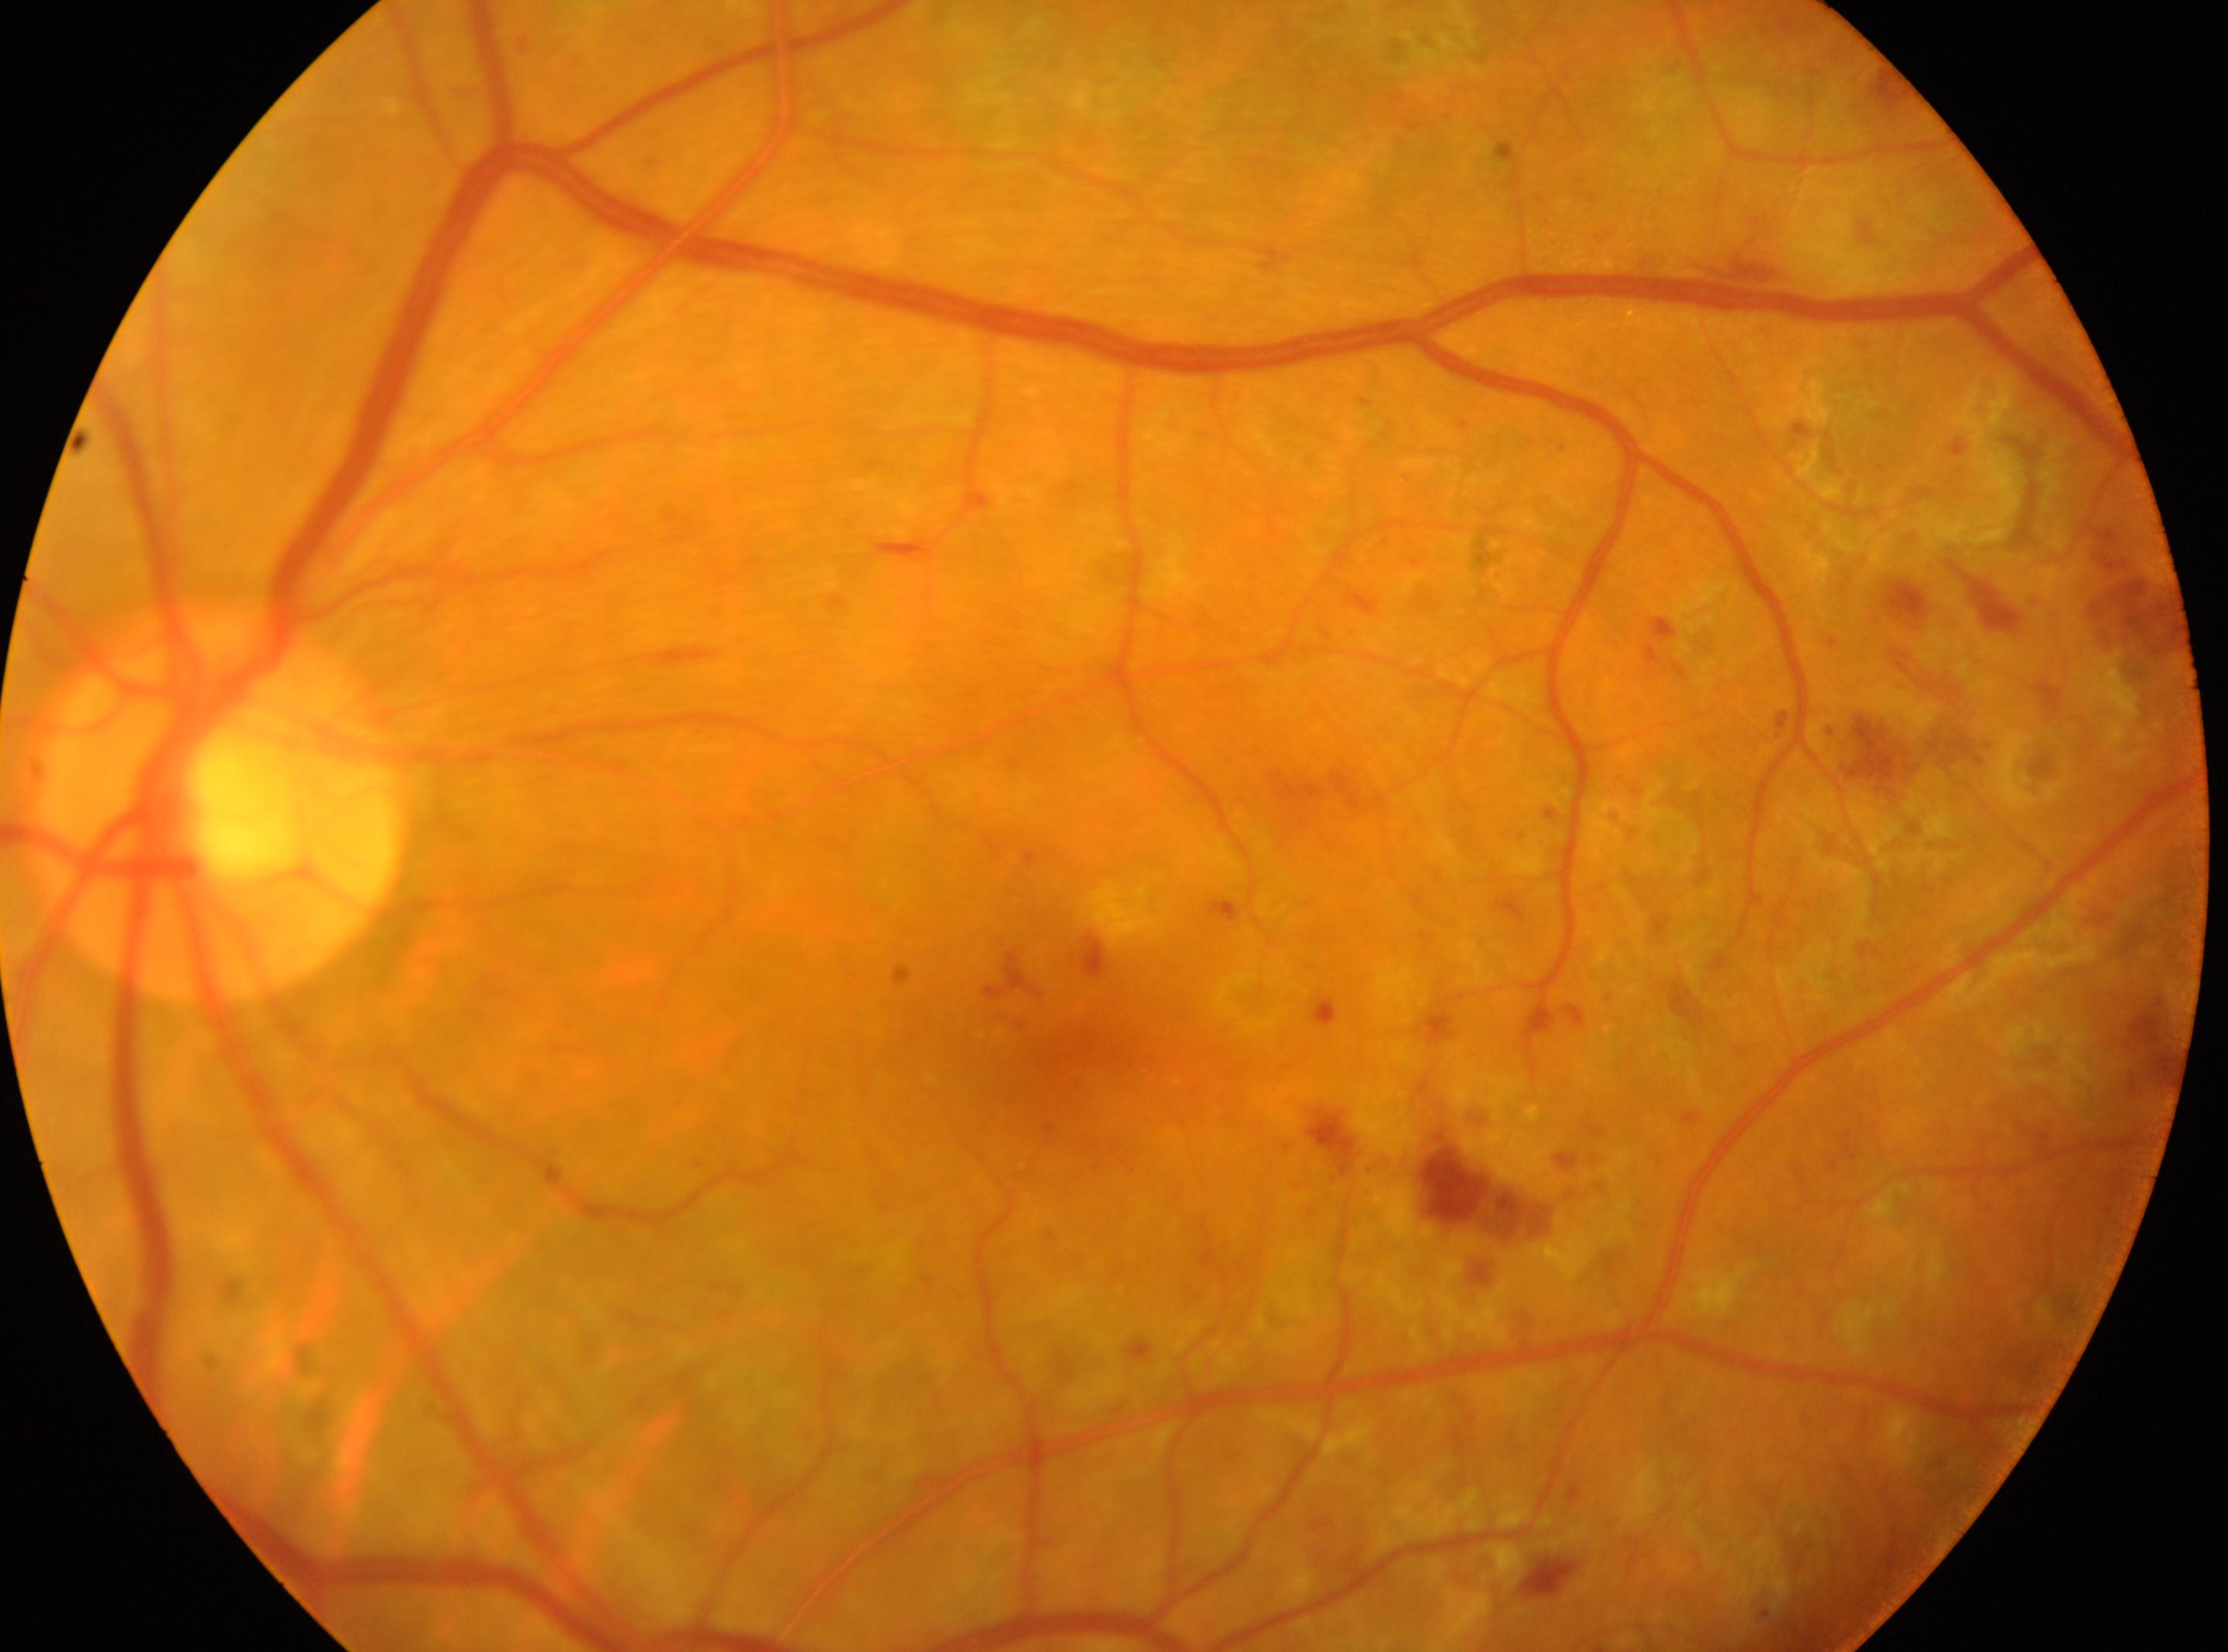 DR: post-laser DR, underlying severity moderate non-proliferative diabetic retinopathy (grade 2)
disc center: 218px, 809px
macula center: 1066px, 1043px
laterality: oculus sinister